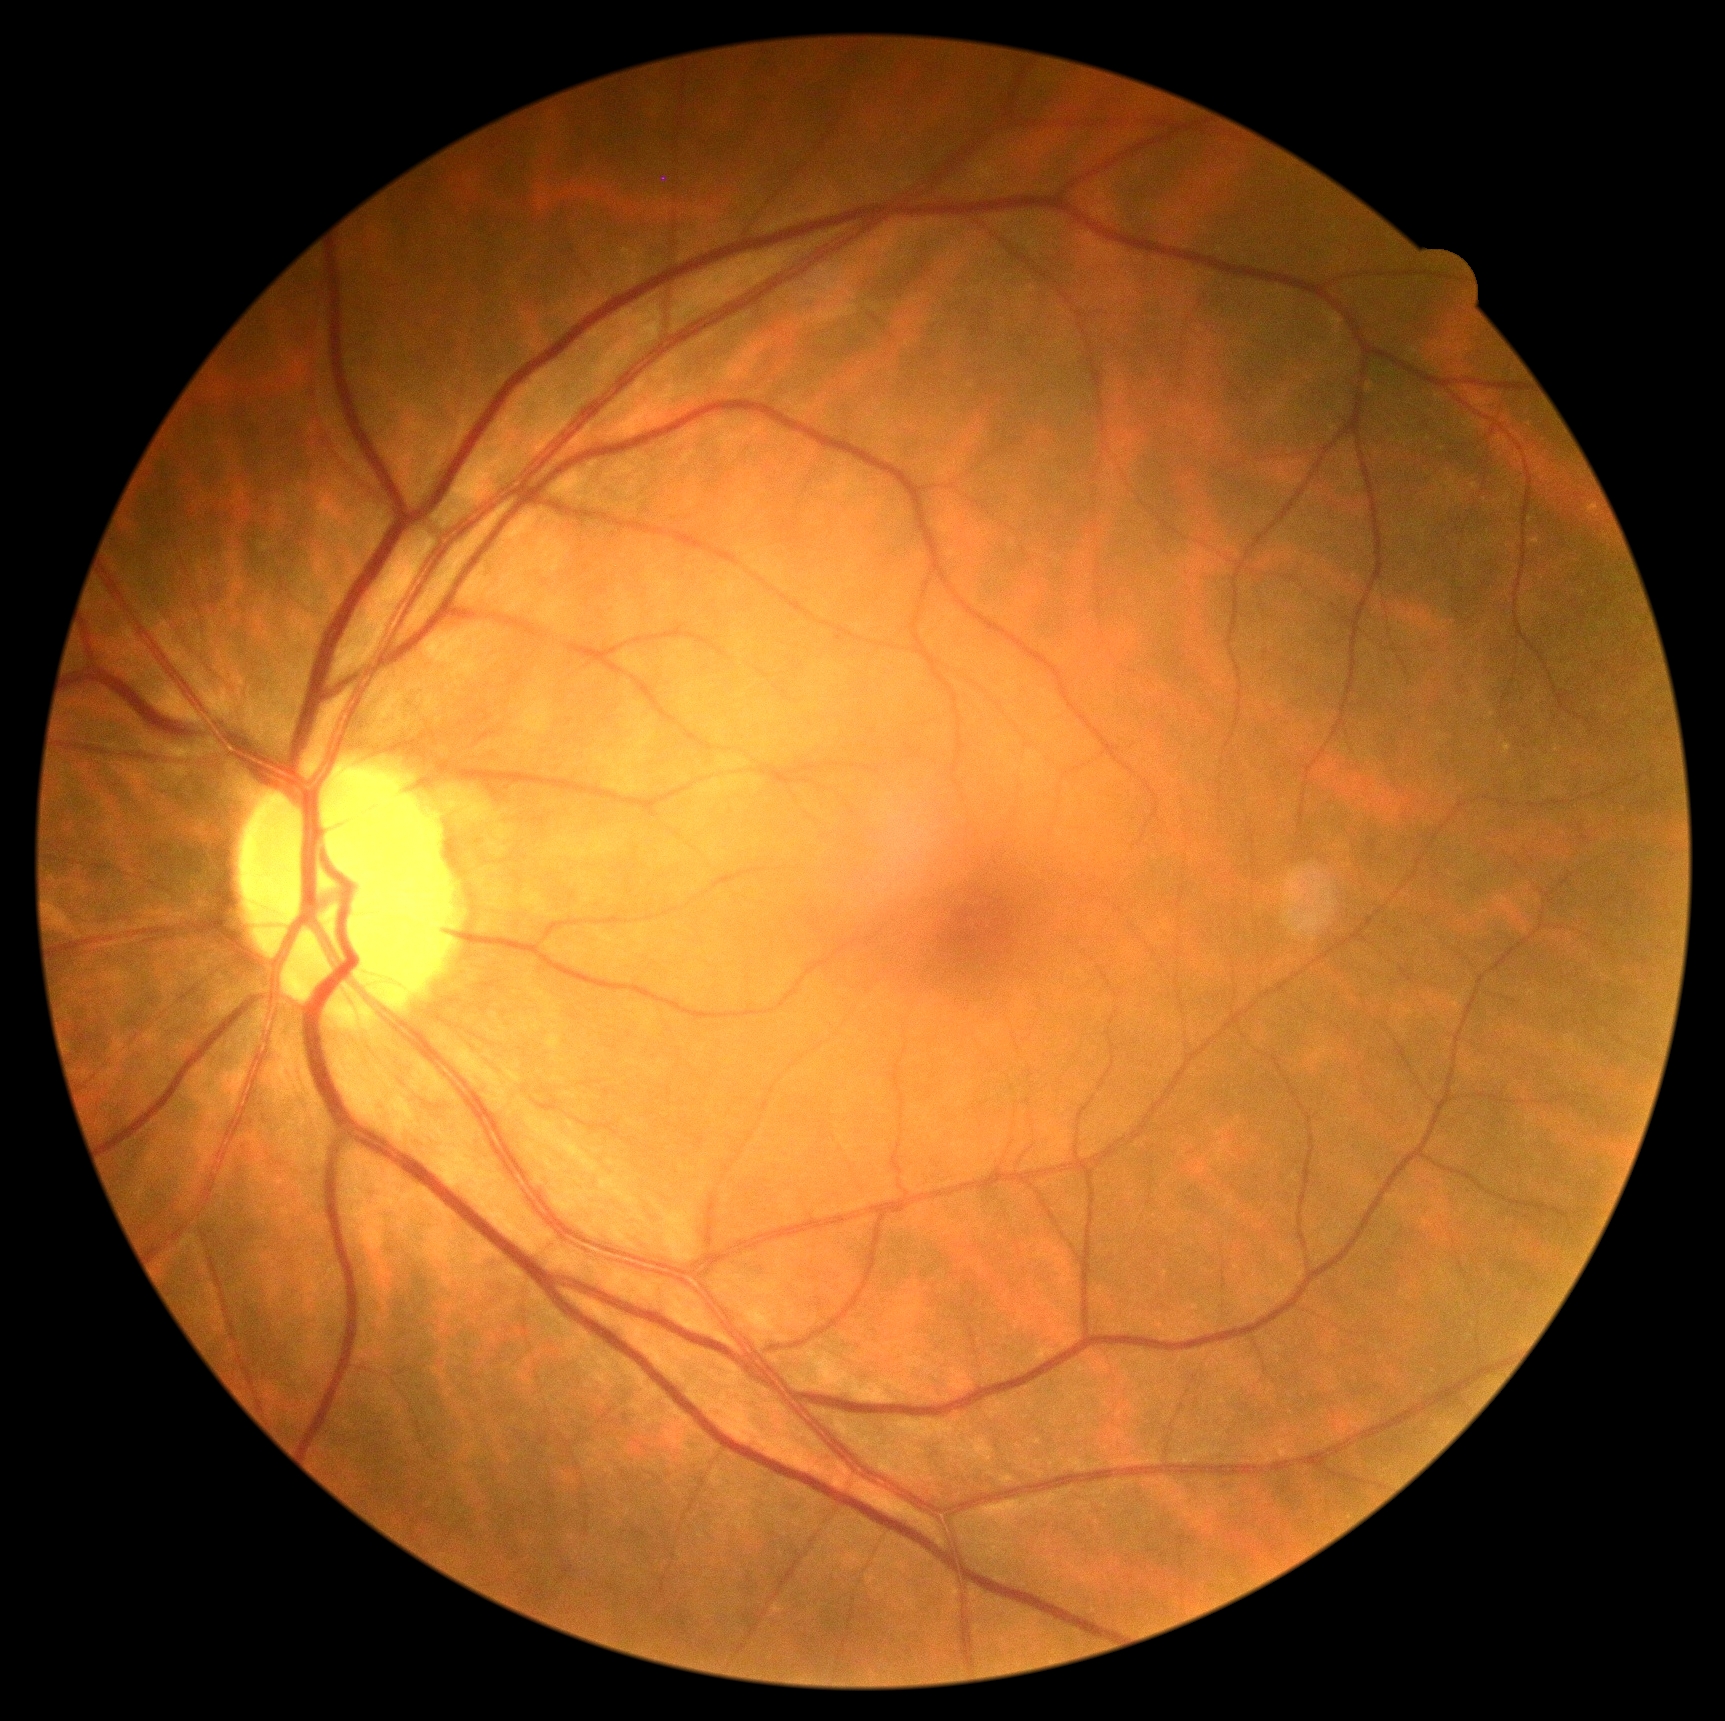

DR is grade 0 (no apparent retinopathy).